Pediatric wide-field fundus photograph. Acquired on the Clarity RetCam 3.
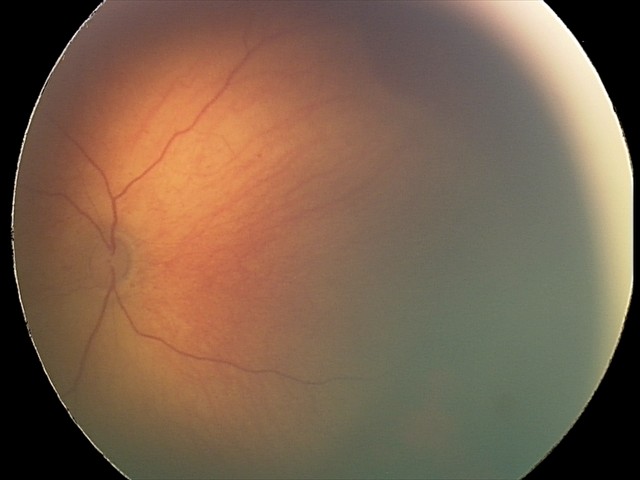

Finding = retinal hemorrhages.